2184x1682px — 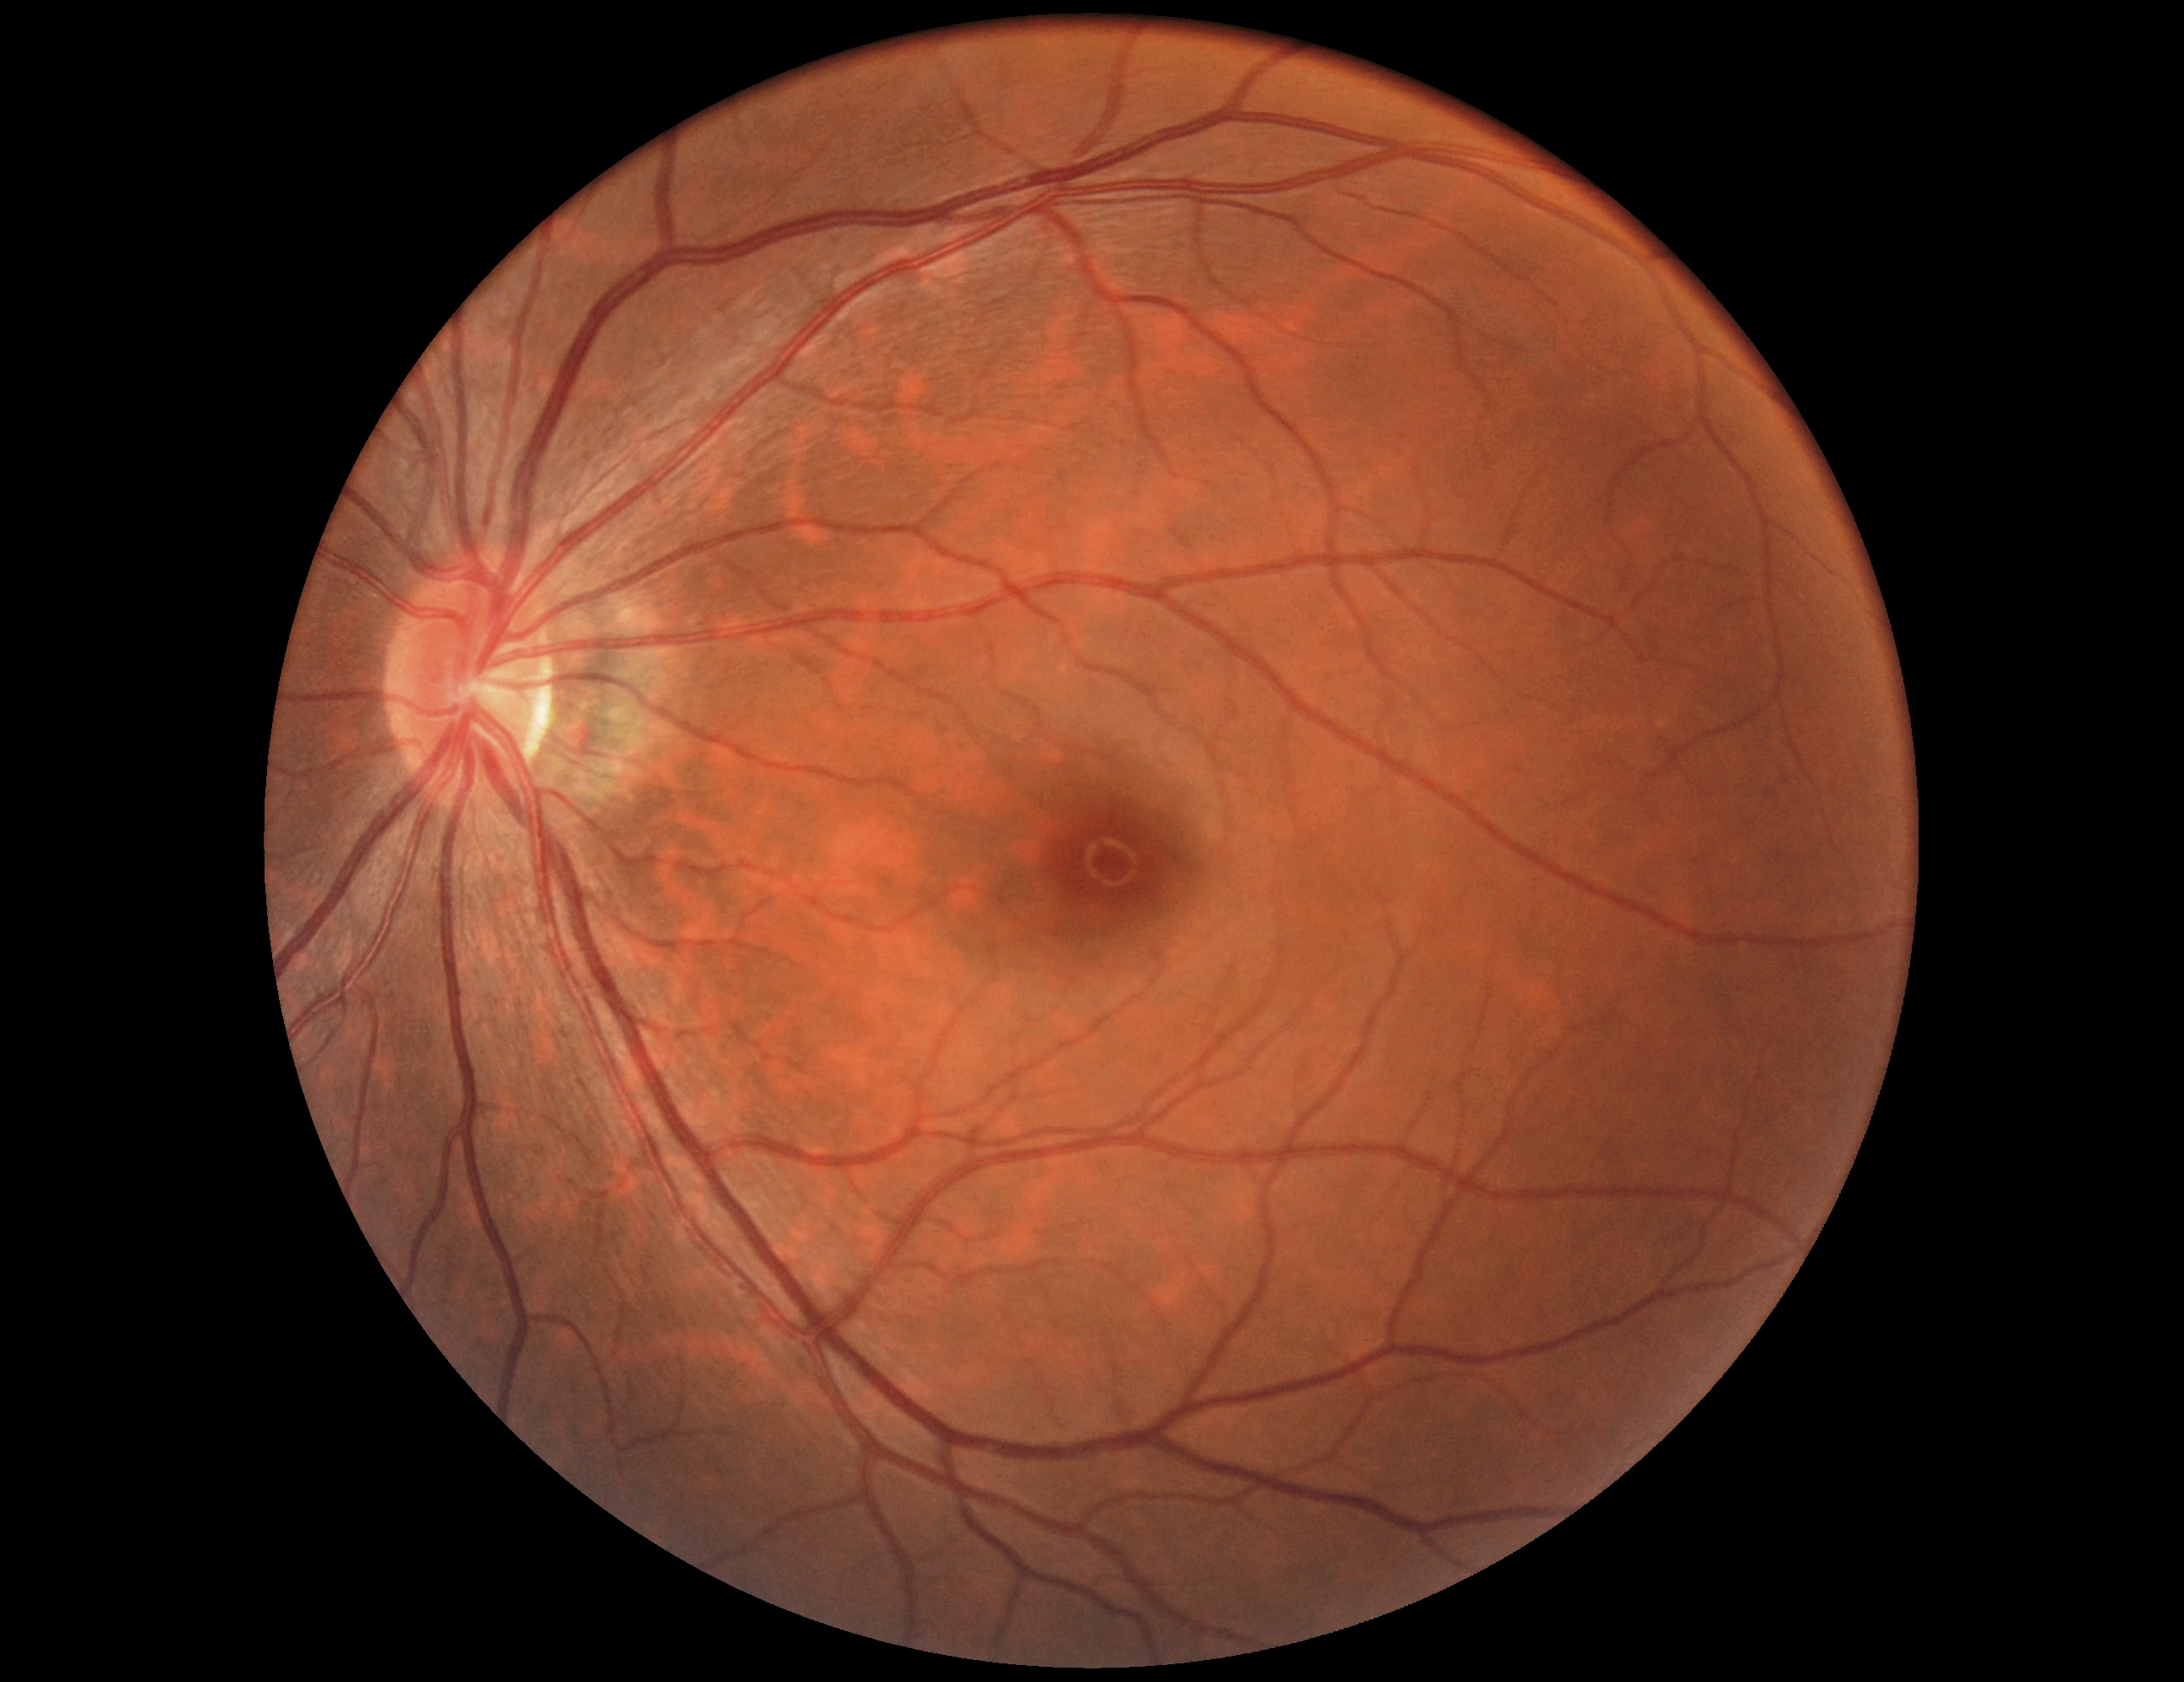 DR is grade 0. No signs of diabetic retinopathy.